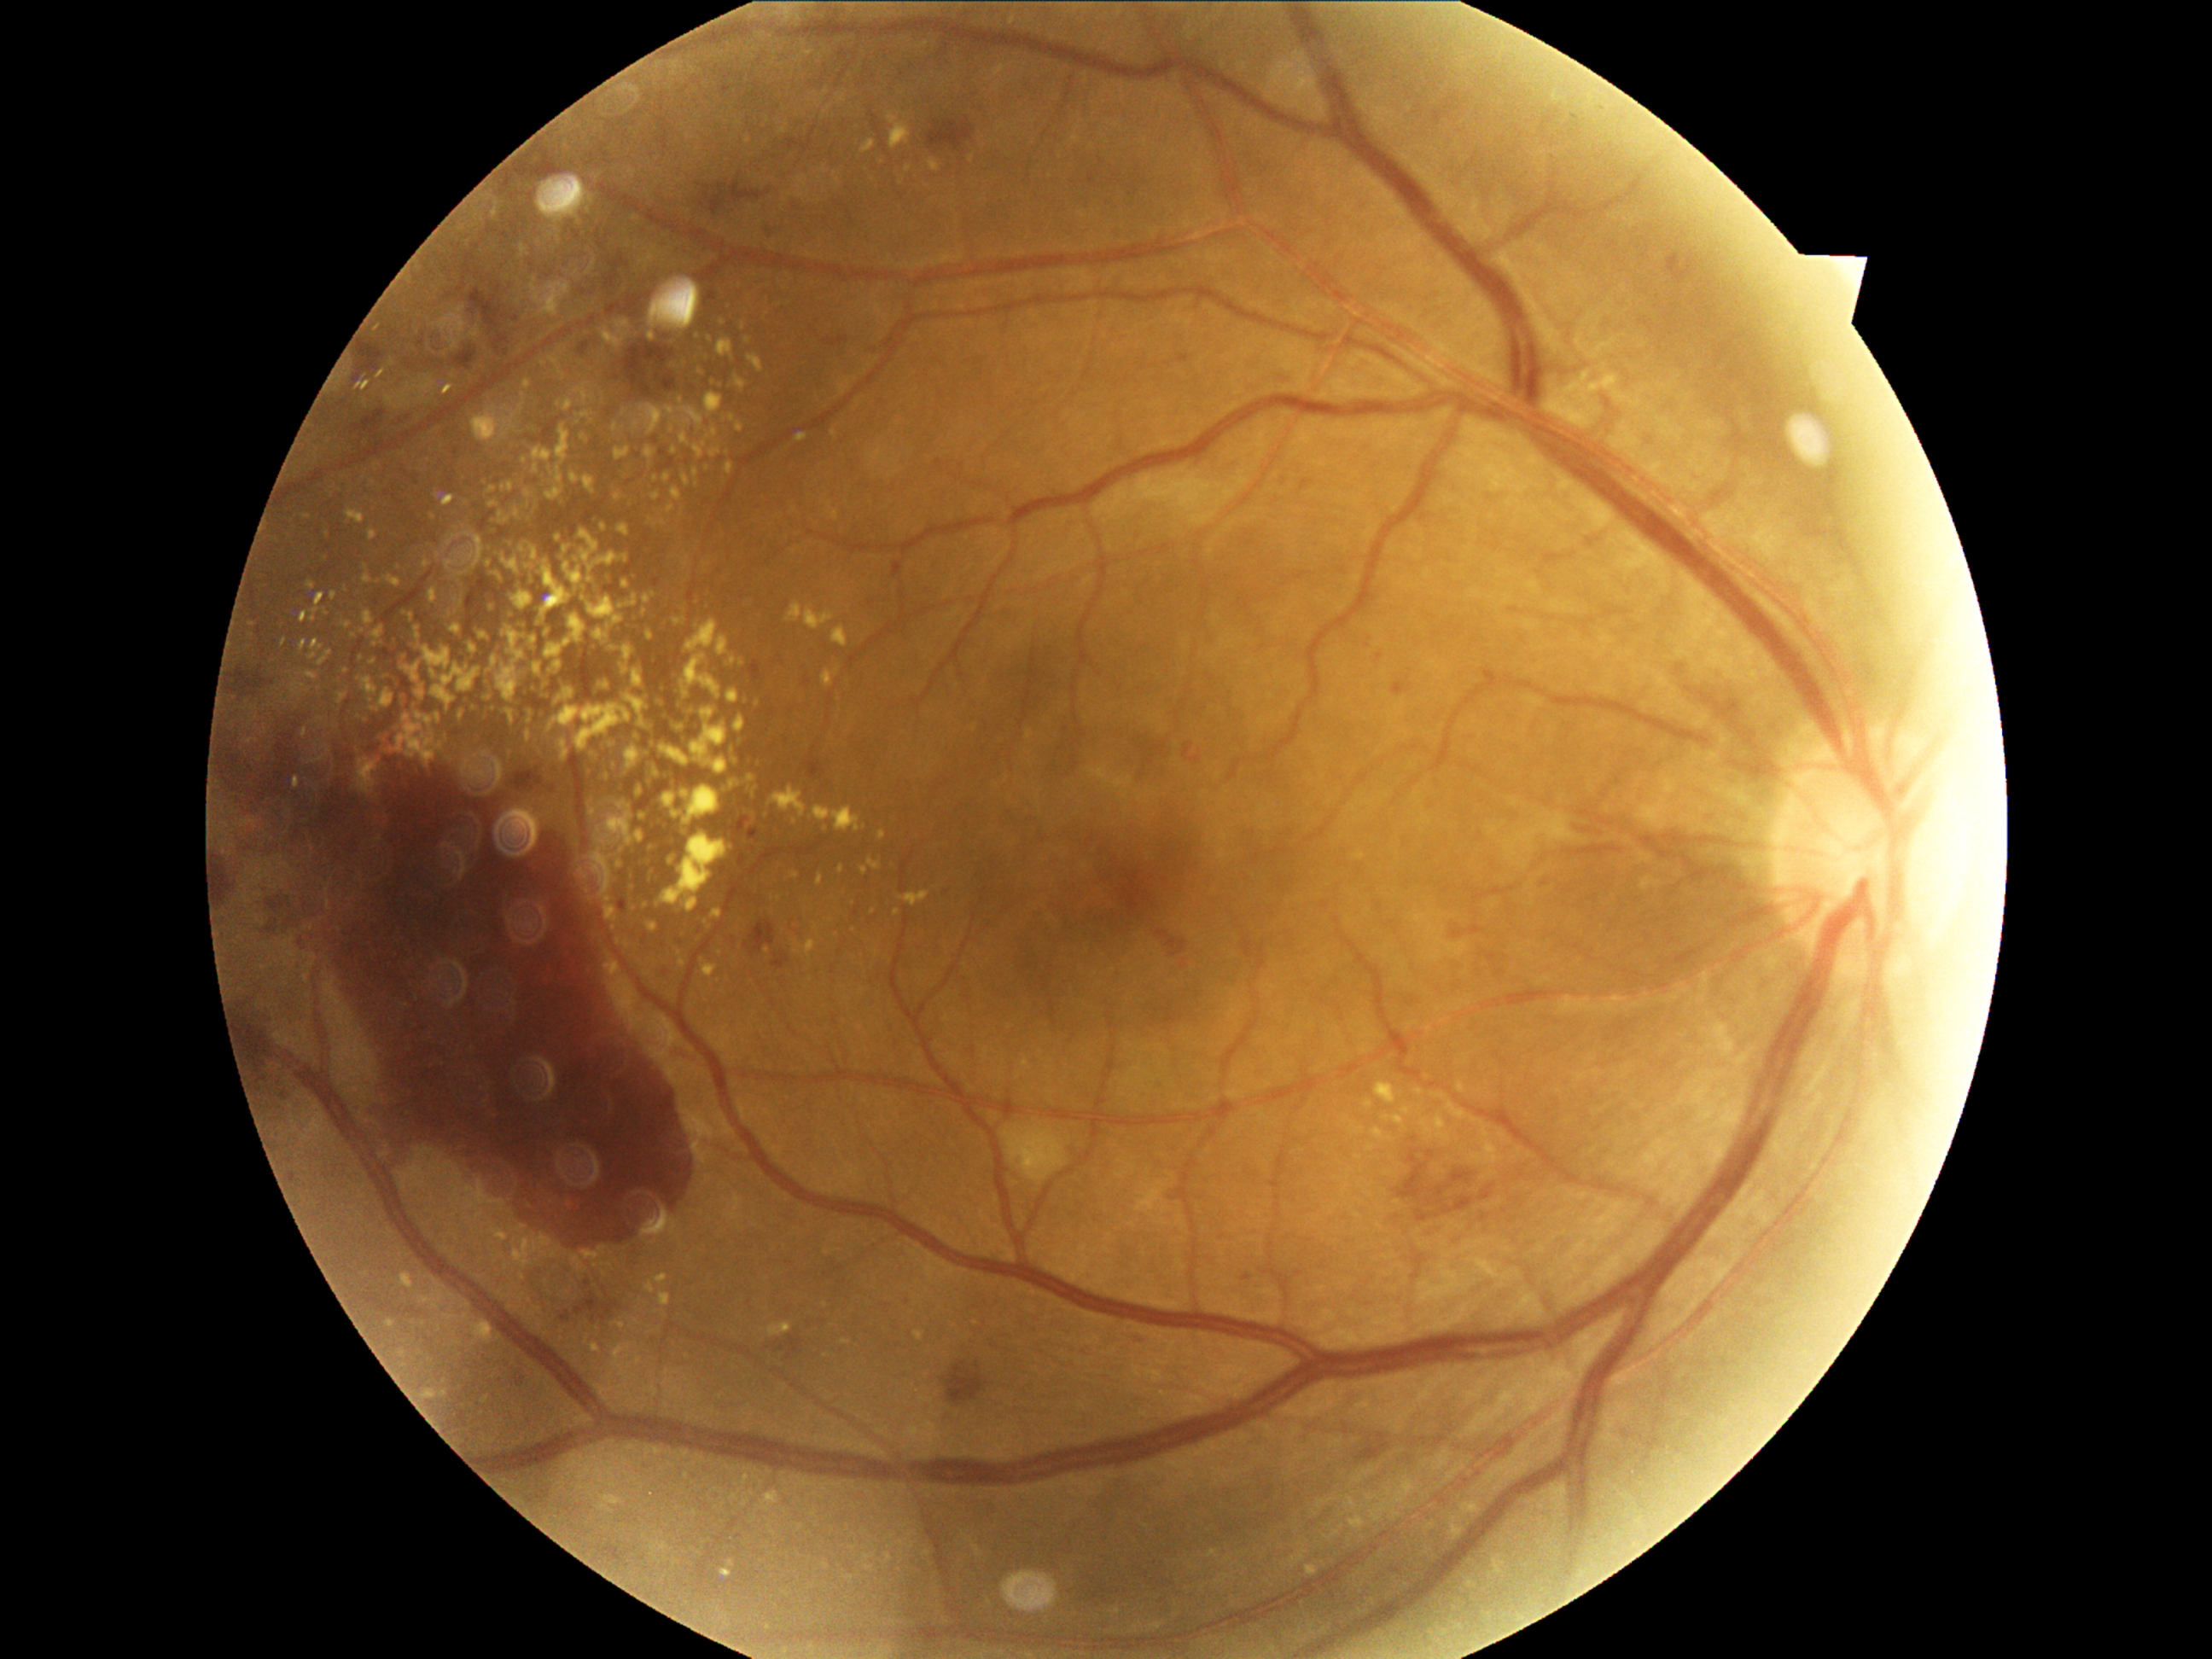
Diabetic retinopathy (DR) is proliferative diabetic retinopathy (grade 4); proliferative diabetic retinopathy
Lesions identified (partial list):
hard exudates (EXs) (subset): (318, 651, 332, 667); (806, 610, 835, 629); (547, 465, 552, 475); (651, 477, 660, 482); (624, 581, 631, 590); (653, 696, 660, 706); (1464, 1503, 1479, 1513); (533, 665, 542, 675); (445, 561, 458, 569); (363, 677, 378, 696); (571, 475, 579, 484); (579, 530, 619, 573)
Small EXs approximately at 623, 607; 523, 628; 636, 426; 487, 719; 726, 452; 675, 362; 525, 697